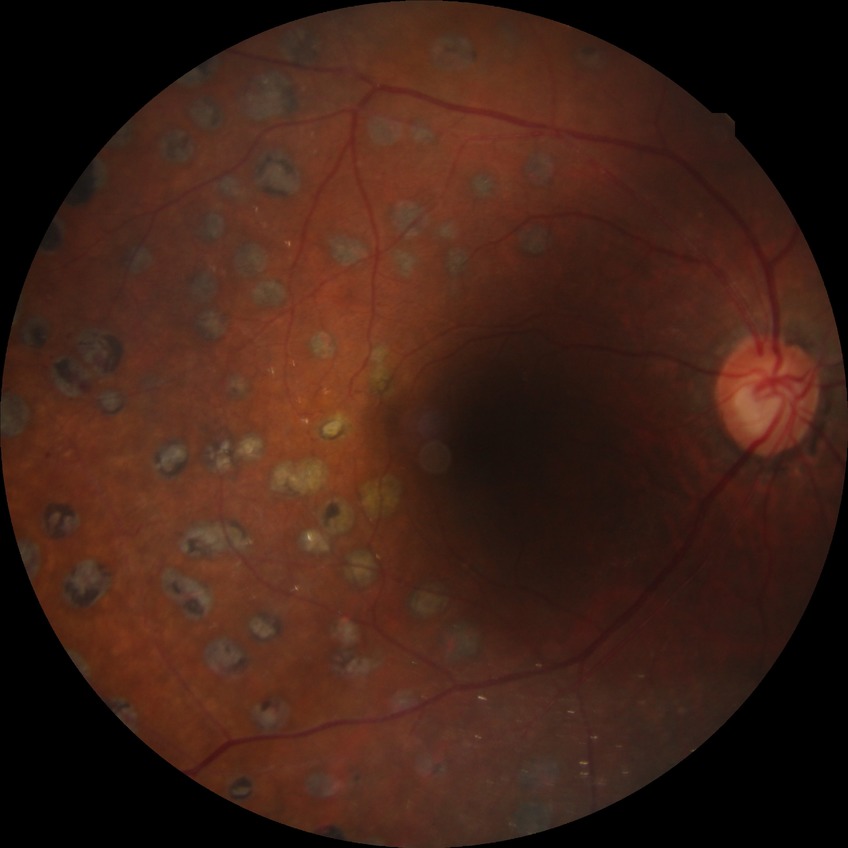

diabetic retinopathy (DR) = PDR (proliferative diabetic retinopathy).